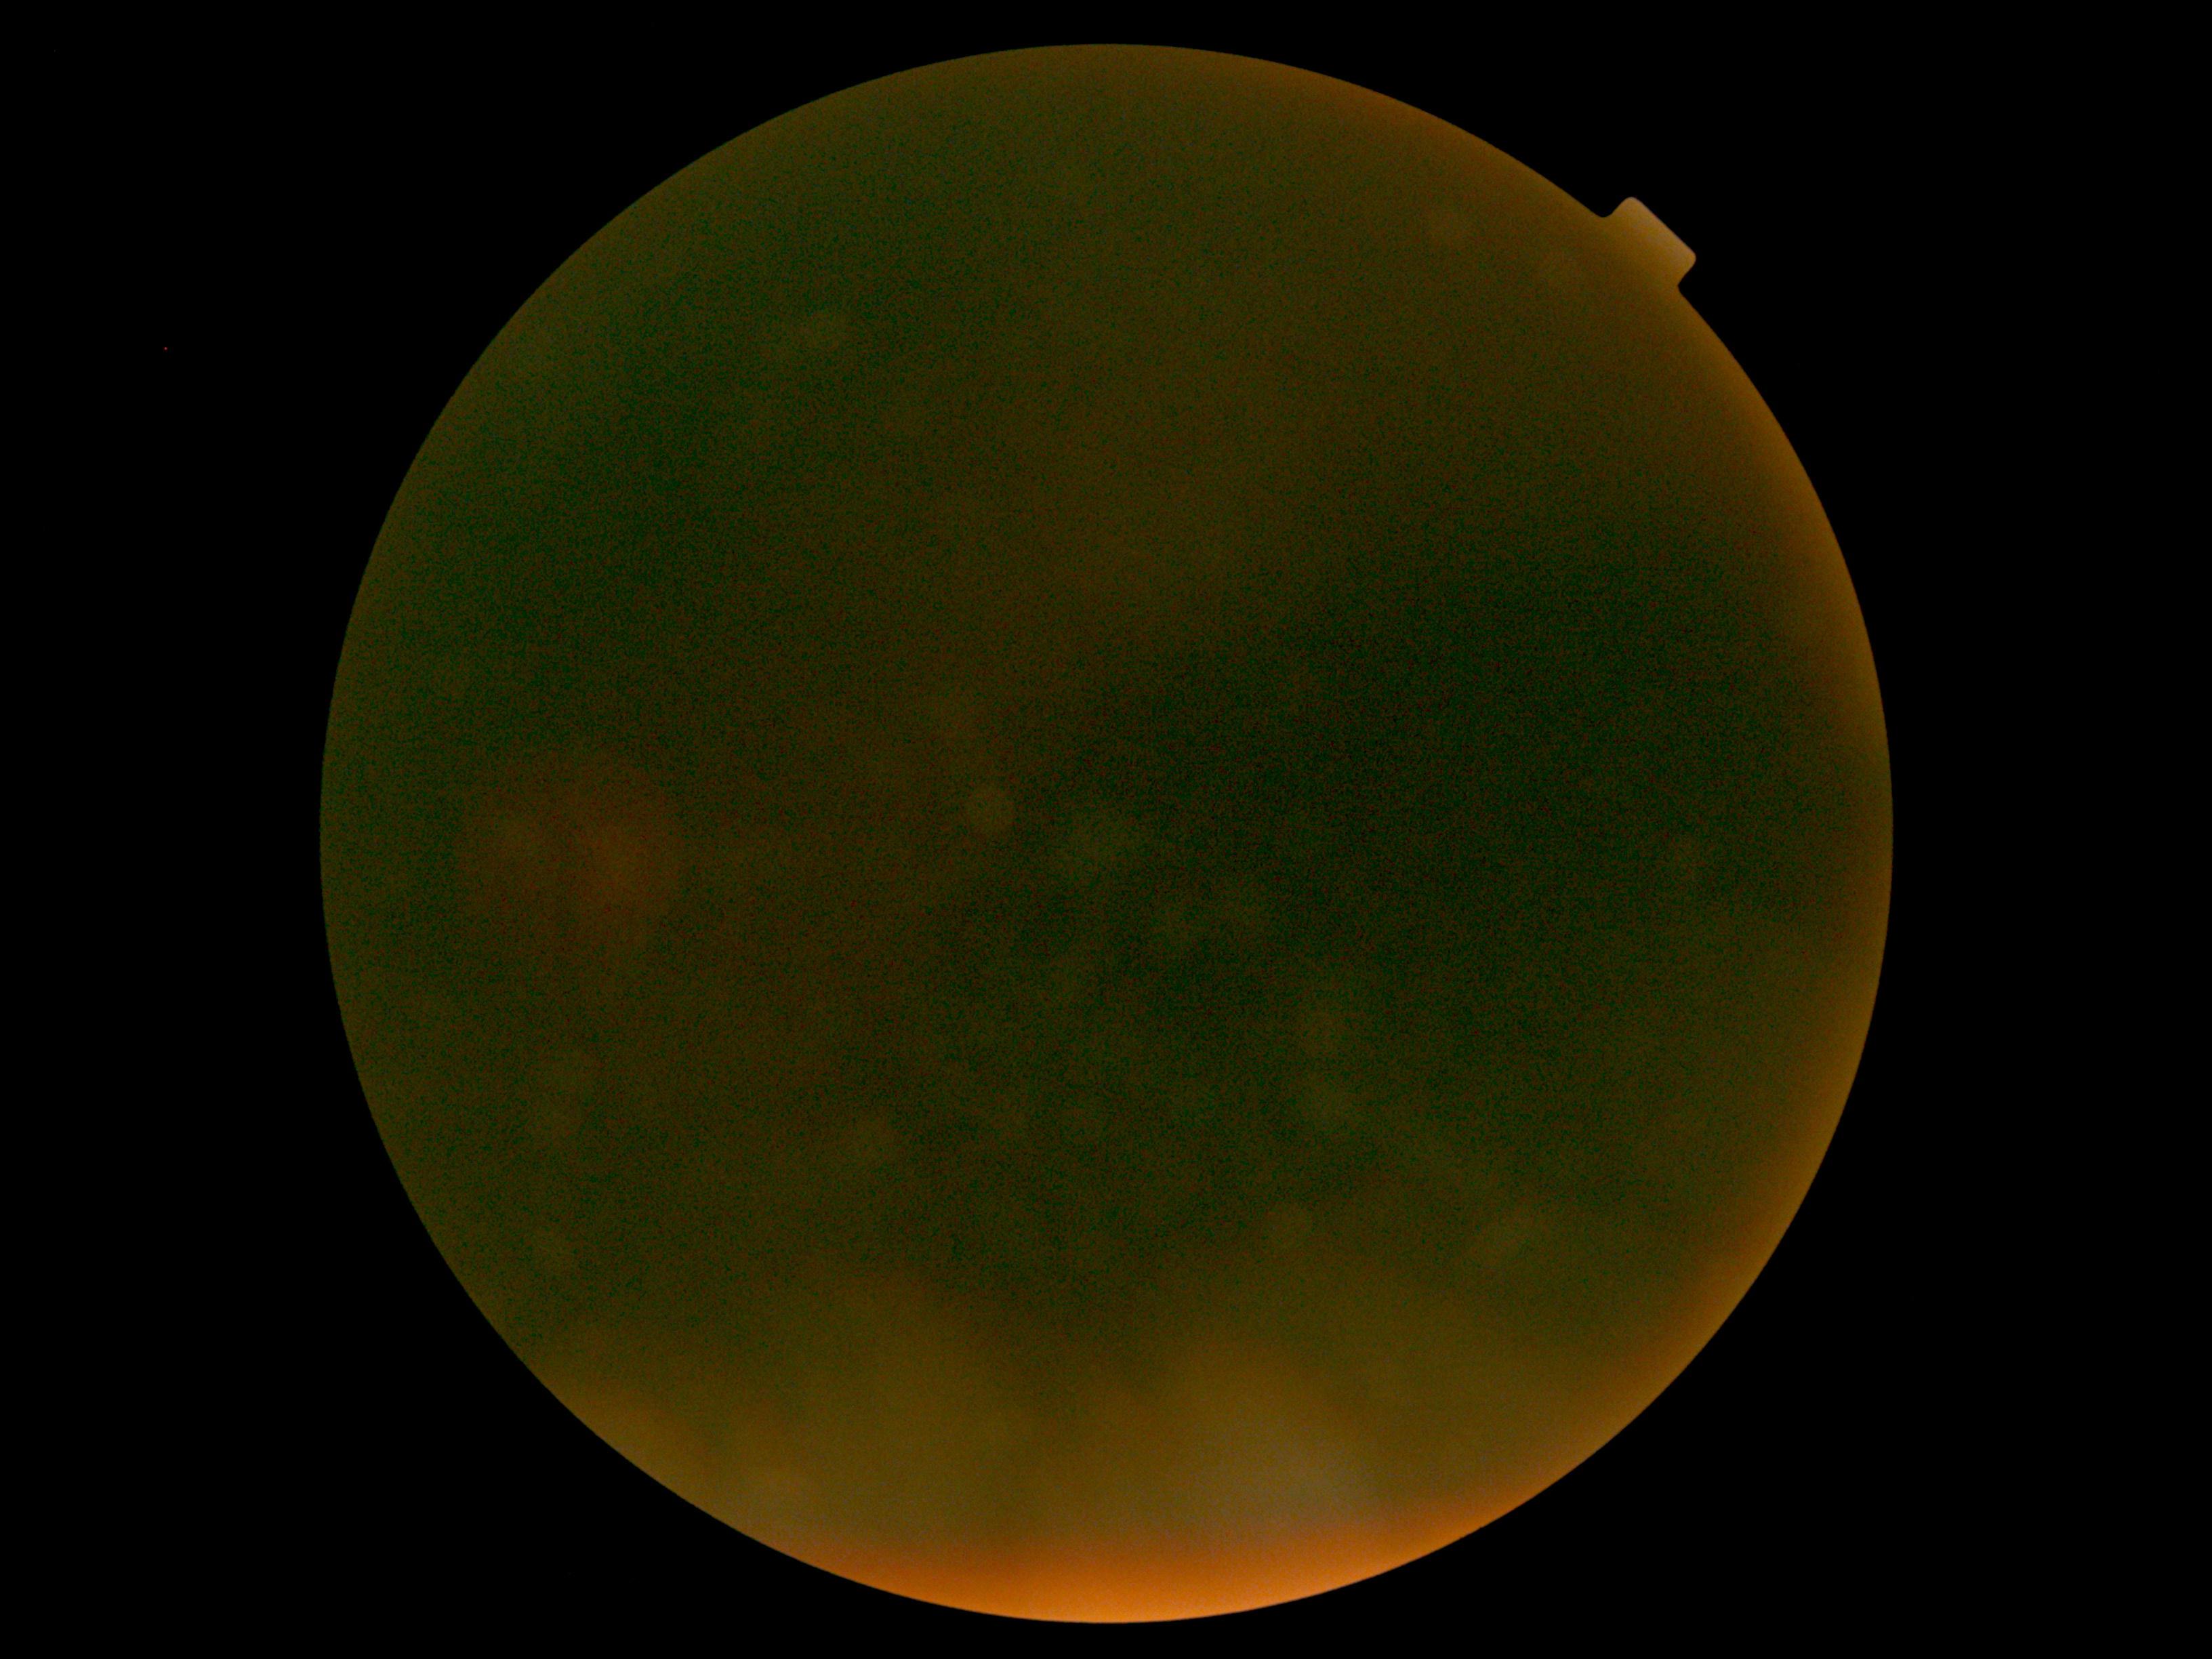
retinopathy = ungradable, image quality = below grading threshold.